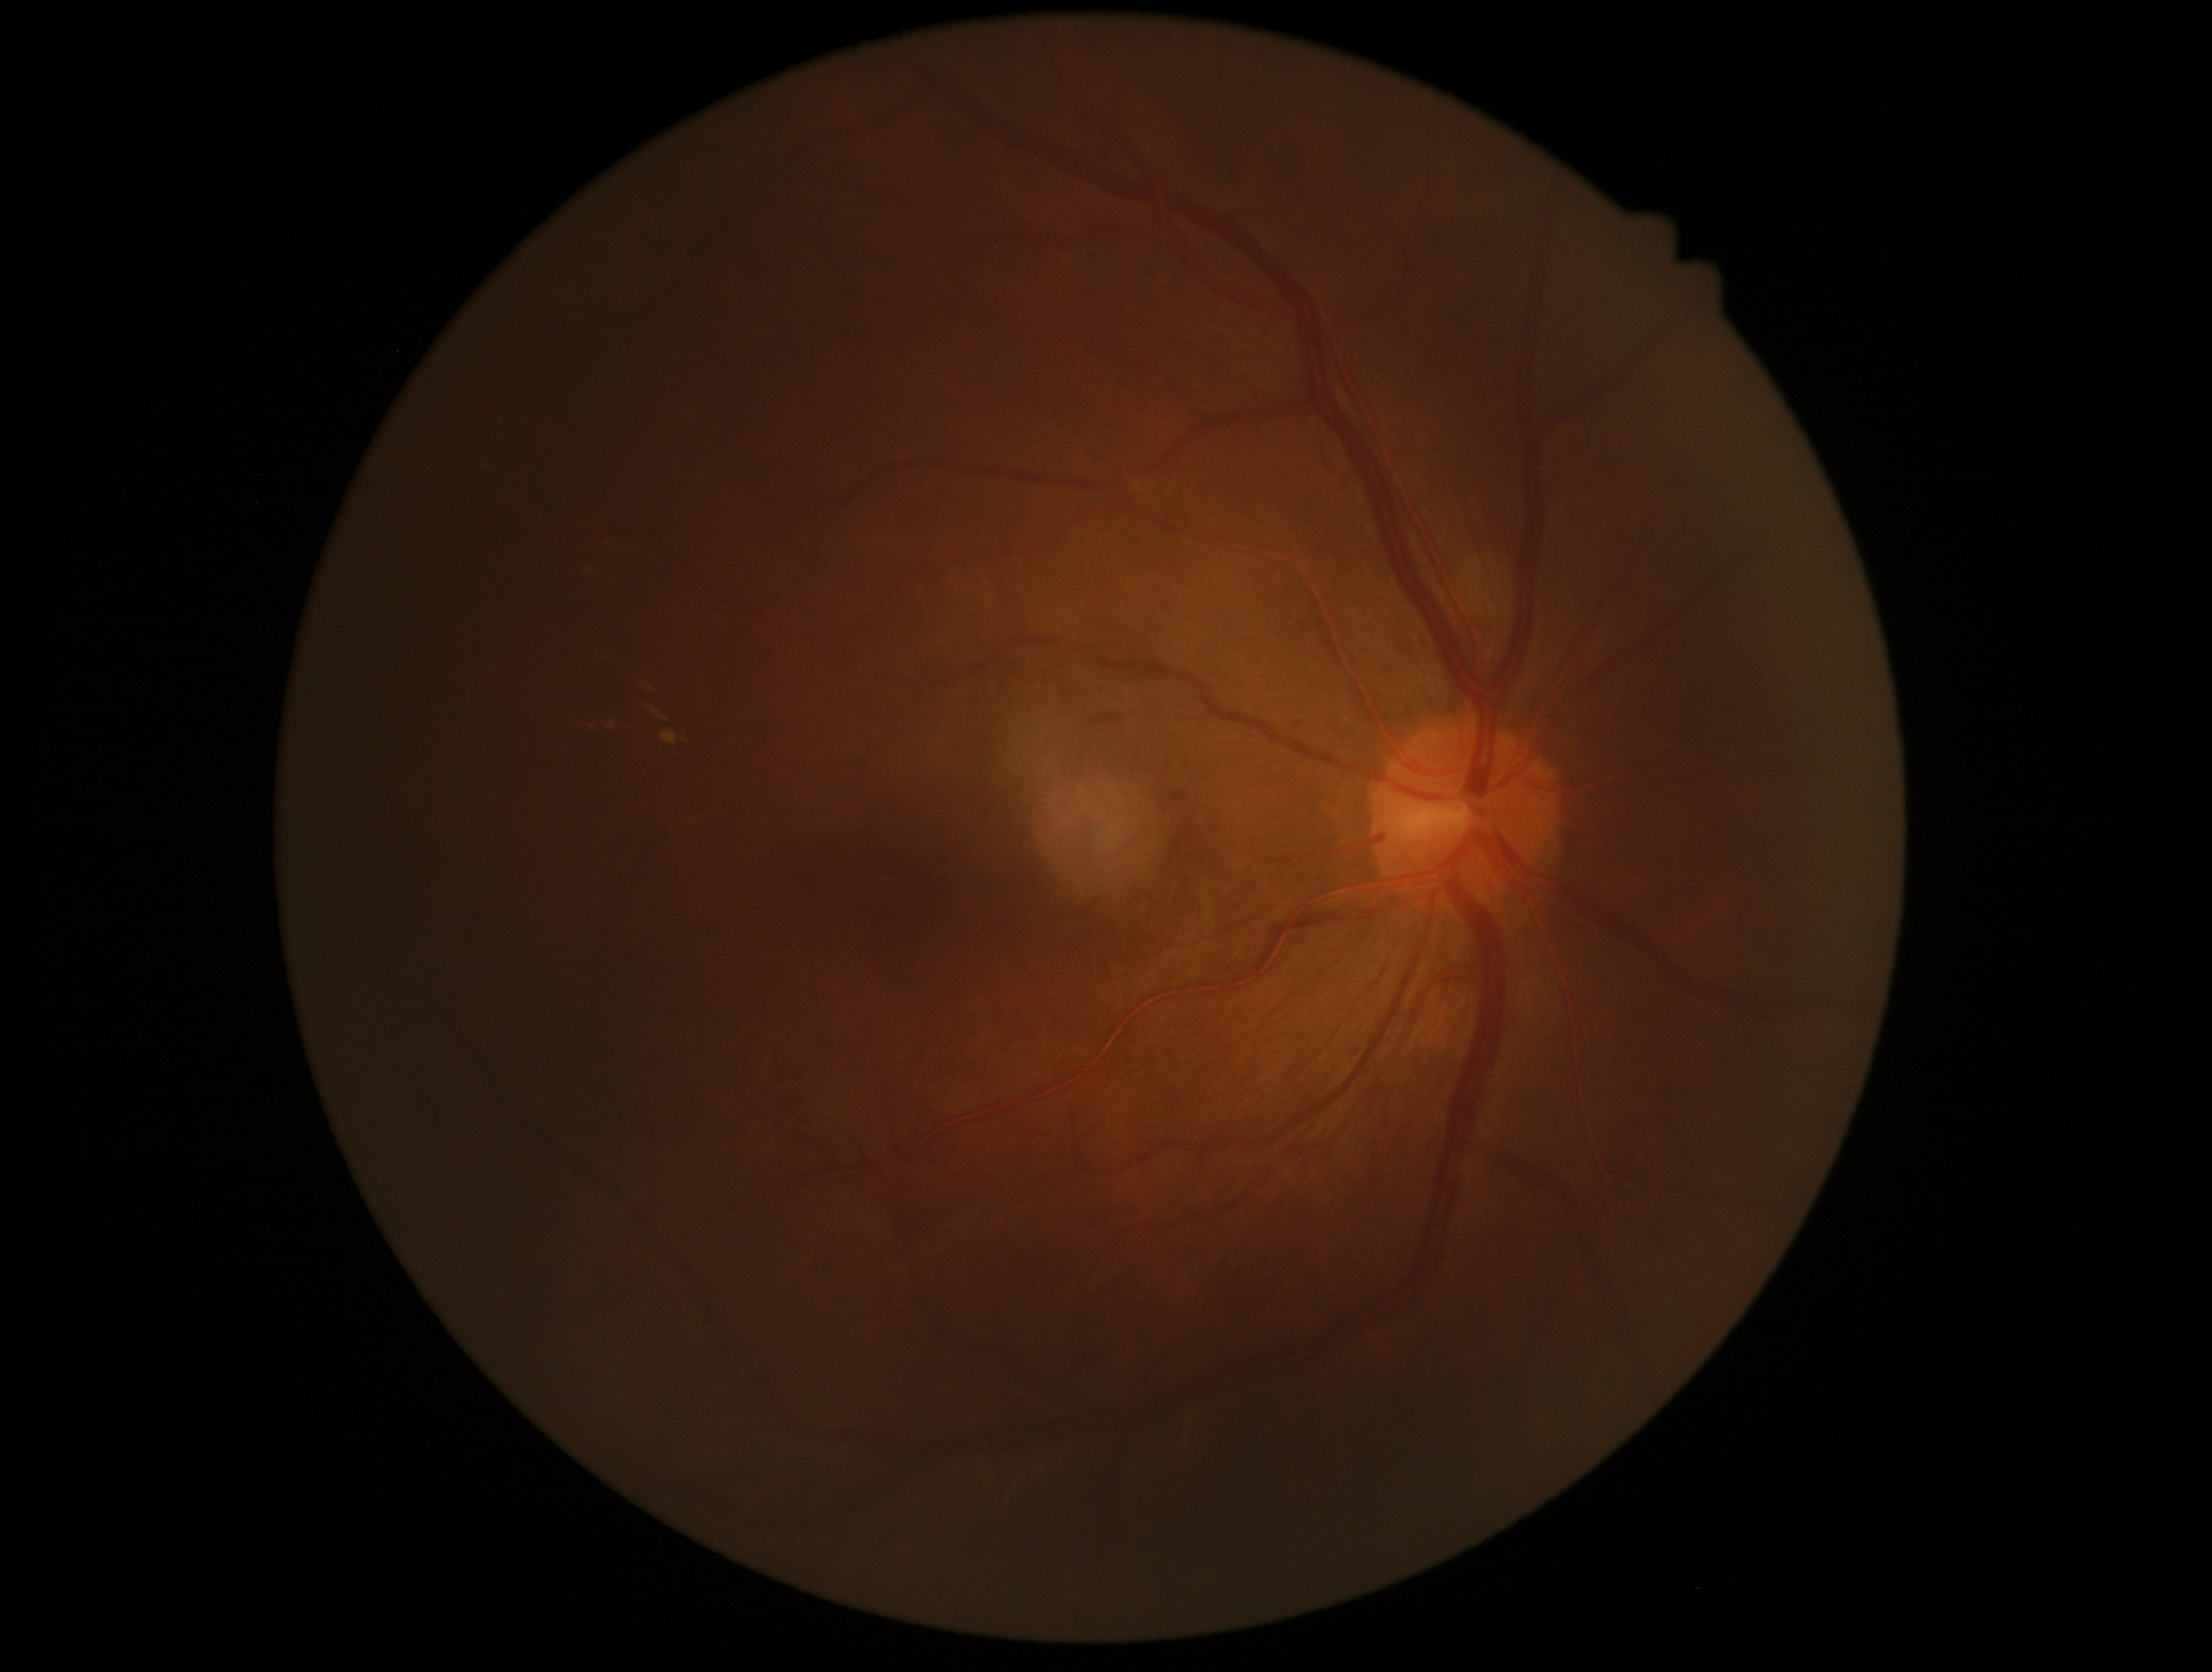
Retinopathy grade: 2. DR class: non-proliferative diabetic retinopathy.